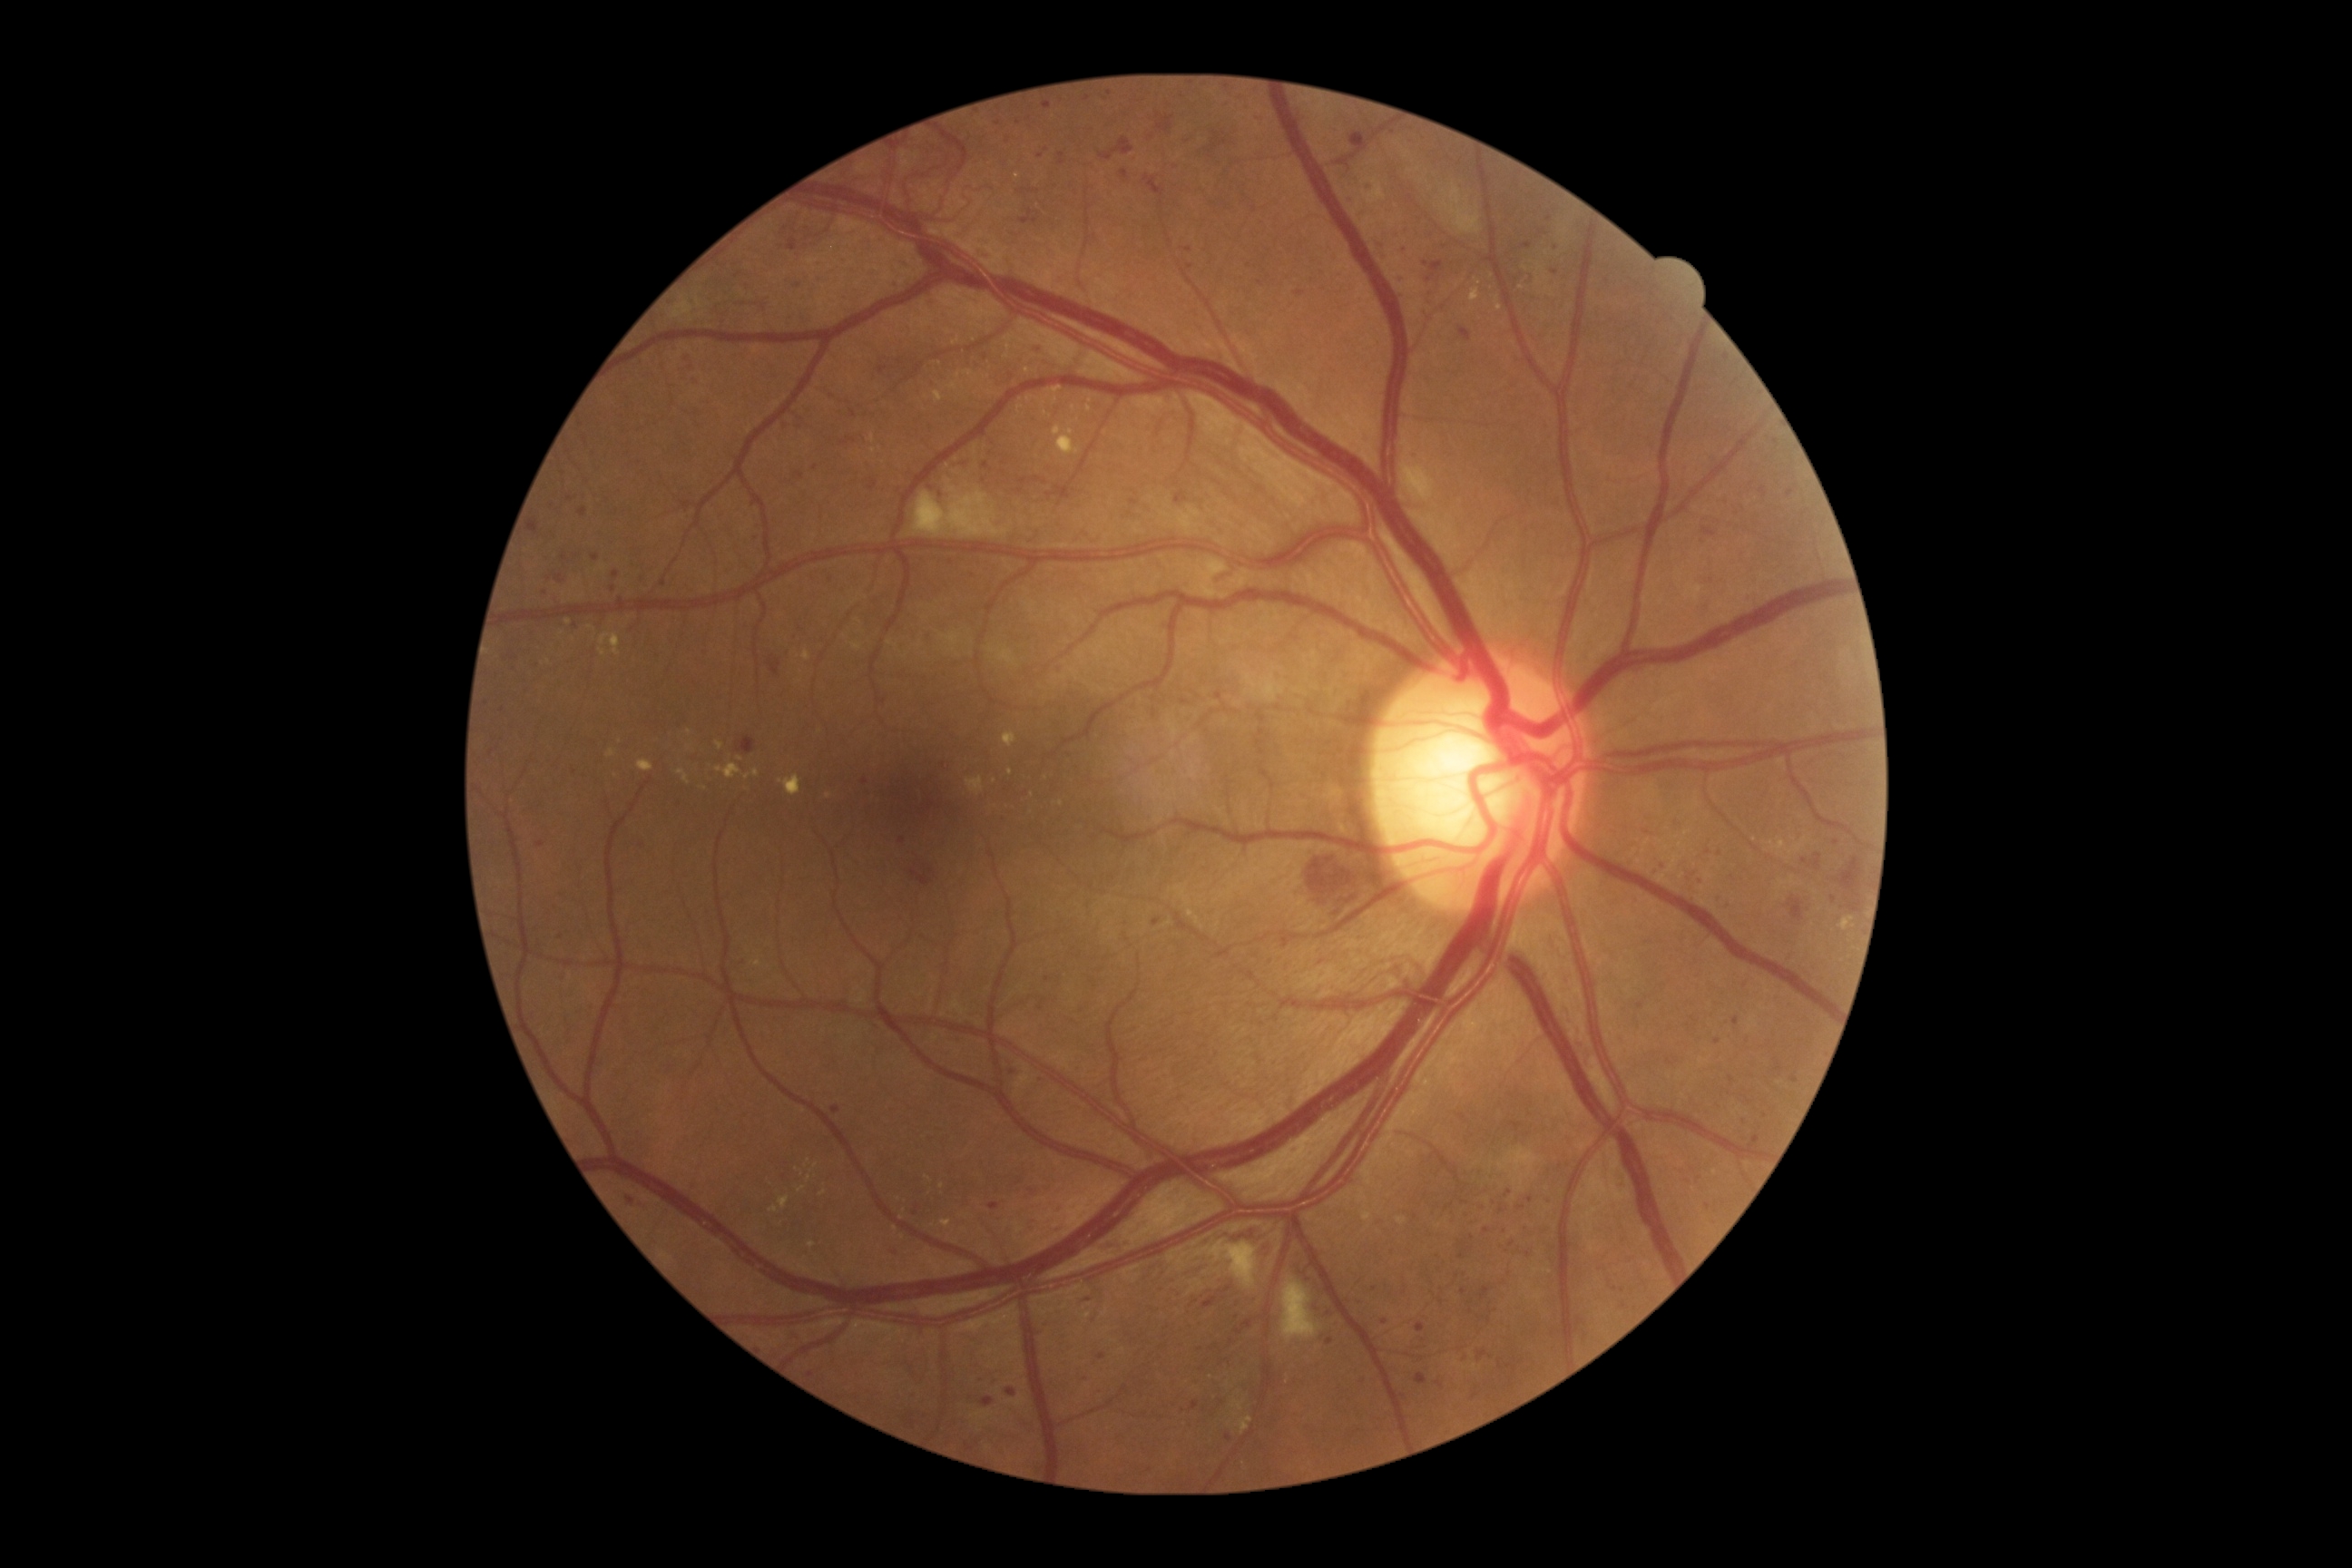
DR grade is 3 (severe NPDR) — more than 20 intraretinal hemorrhages in each of 4 quadrants, definite venous beading in 2 or more quadrants, or prominent intraretinal microvascular abnormalities in 1 or more quadrants, with no signs of proliferative retinopathy; non-proliferative diabetic retinopathy. MAs include box(1130, 500, 1139, 507) | box(966, 1444, 974, 1451) | box(1006, 1387, 1017, 1396) | box(1460, 328, 1471, 342) | box(1242, 92, 1251, 97) | box(1415, 1375, 1427, 1386) | box(1052, 1226, 1063, 1233) | box(1787, 489, 1794, 498) | box(1059, 153, 1066, 166). Smaller MAs around 1465, 1246 | 1190, 267 | 570, 499 | 785, 426 | 1521, 1208 | 1261, 284 | 1731, 1080 | 1012, 1072 | 986, 358 | 1511, 1245.